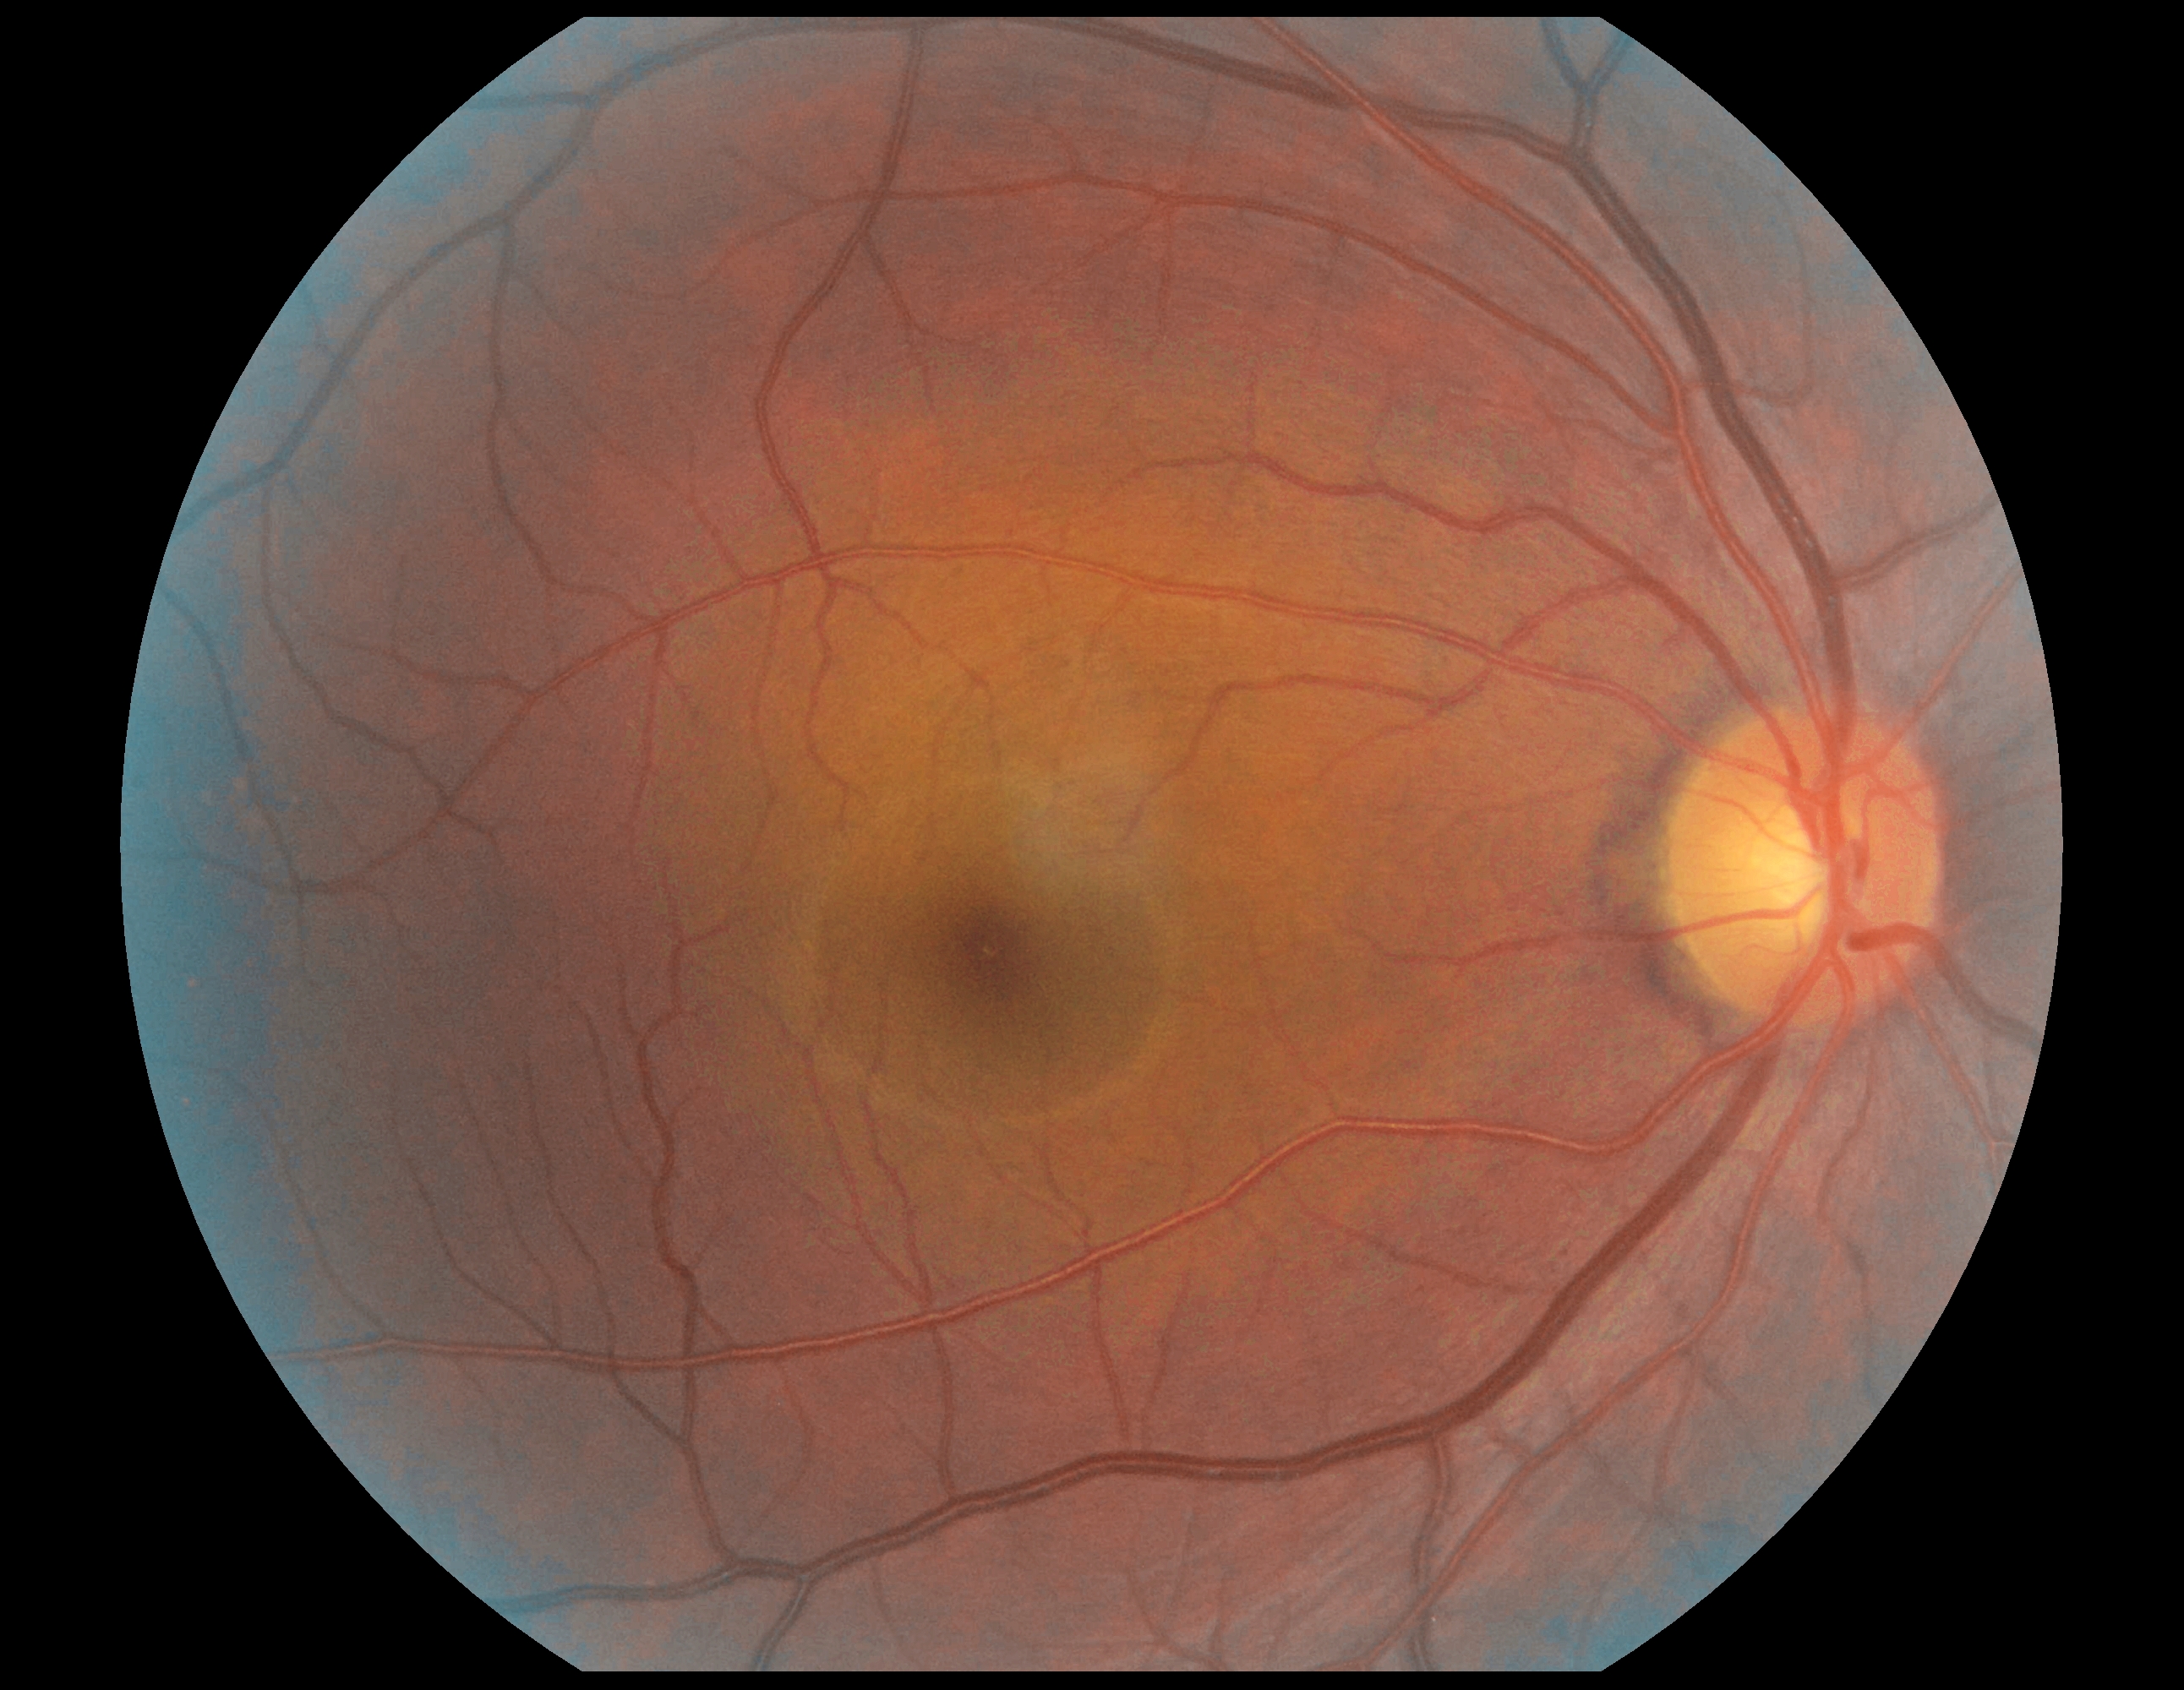 DR severity = no apparent retinopathy (grade 0).